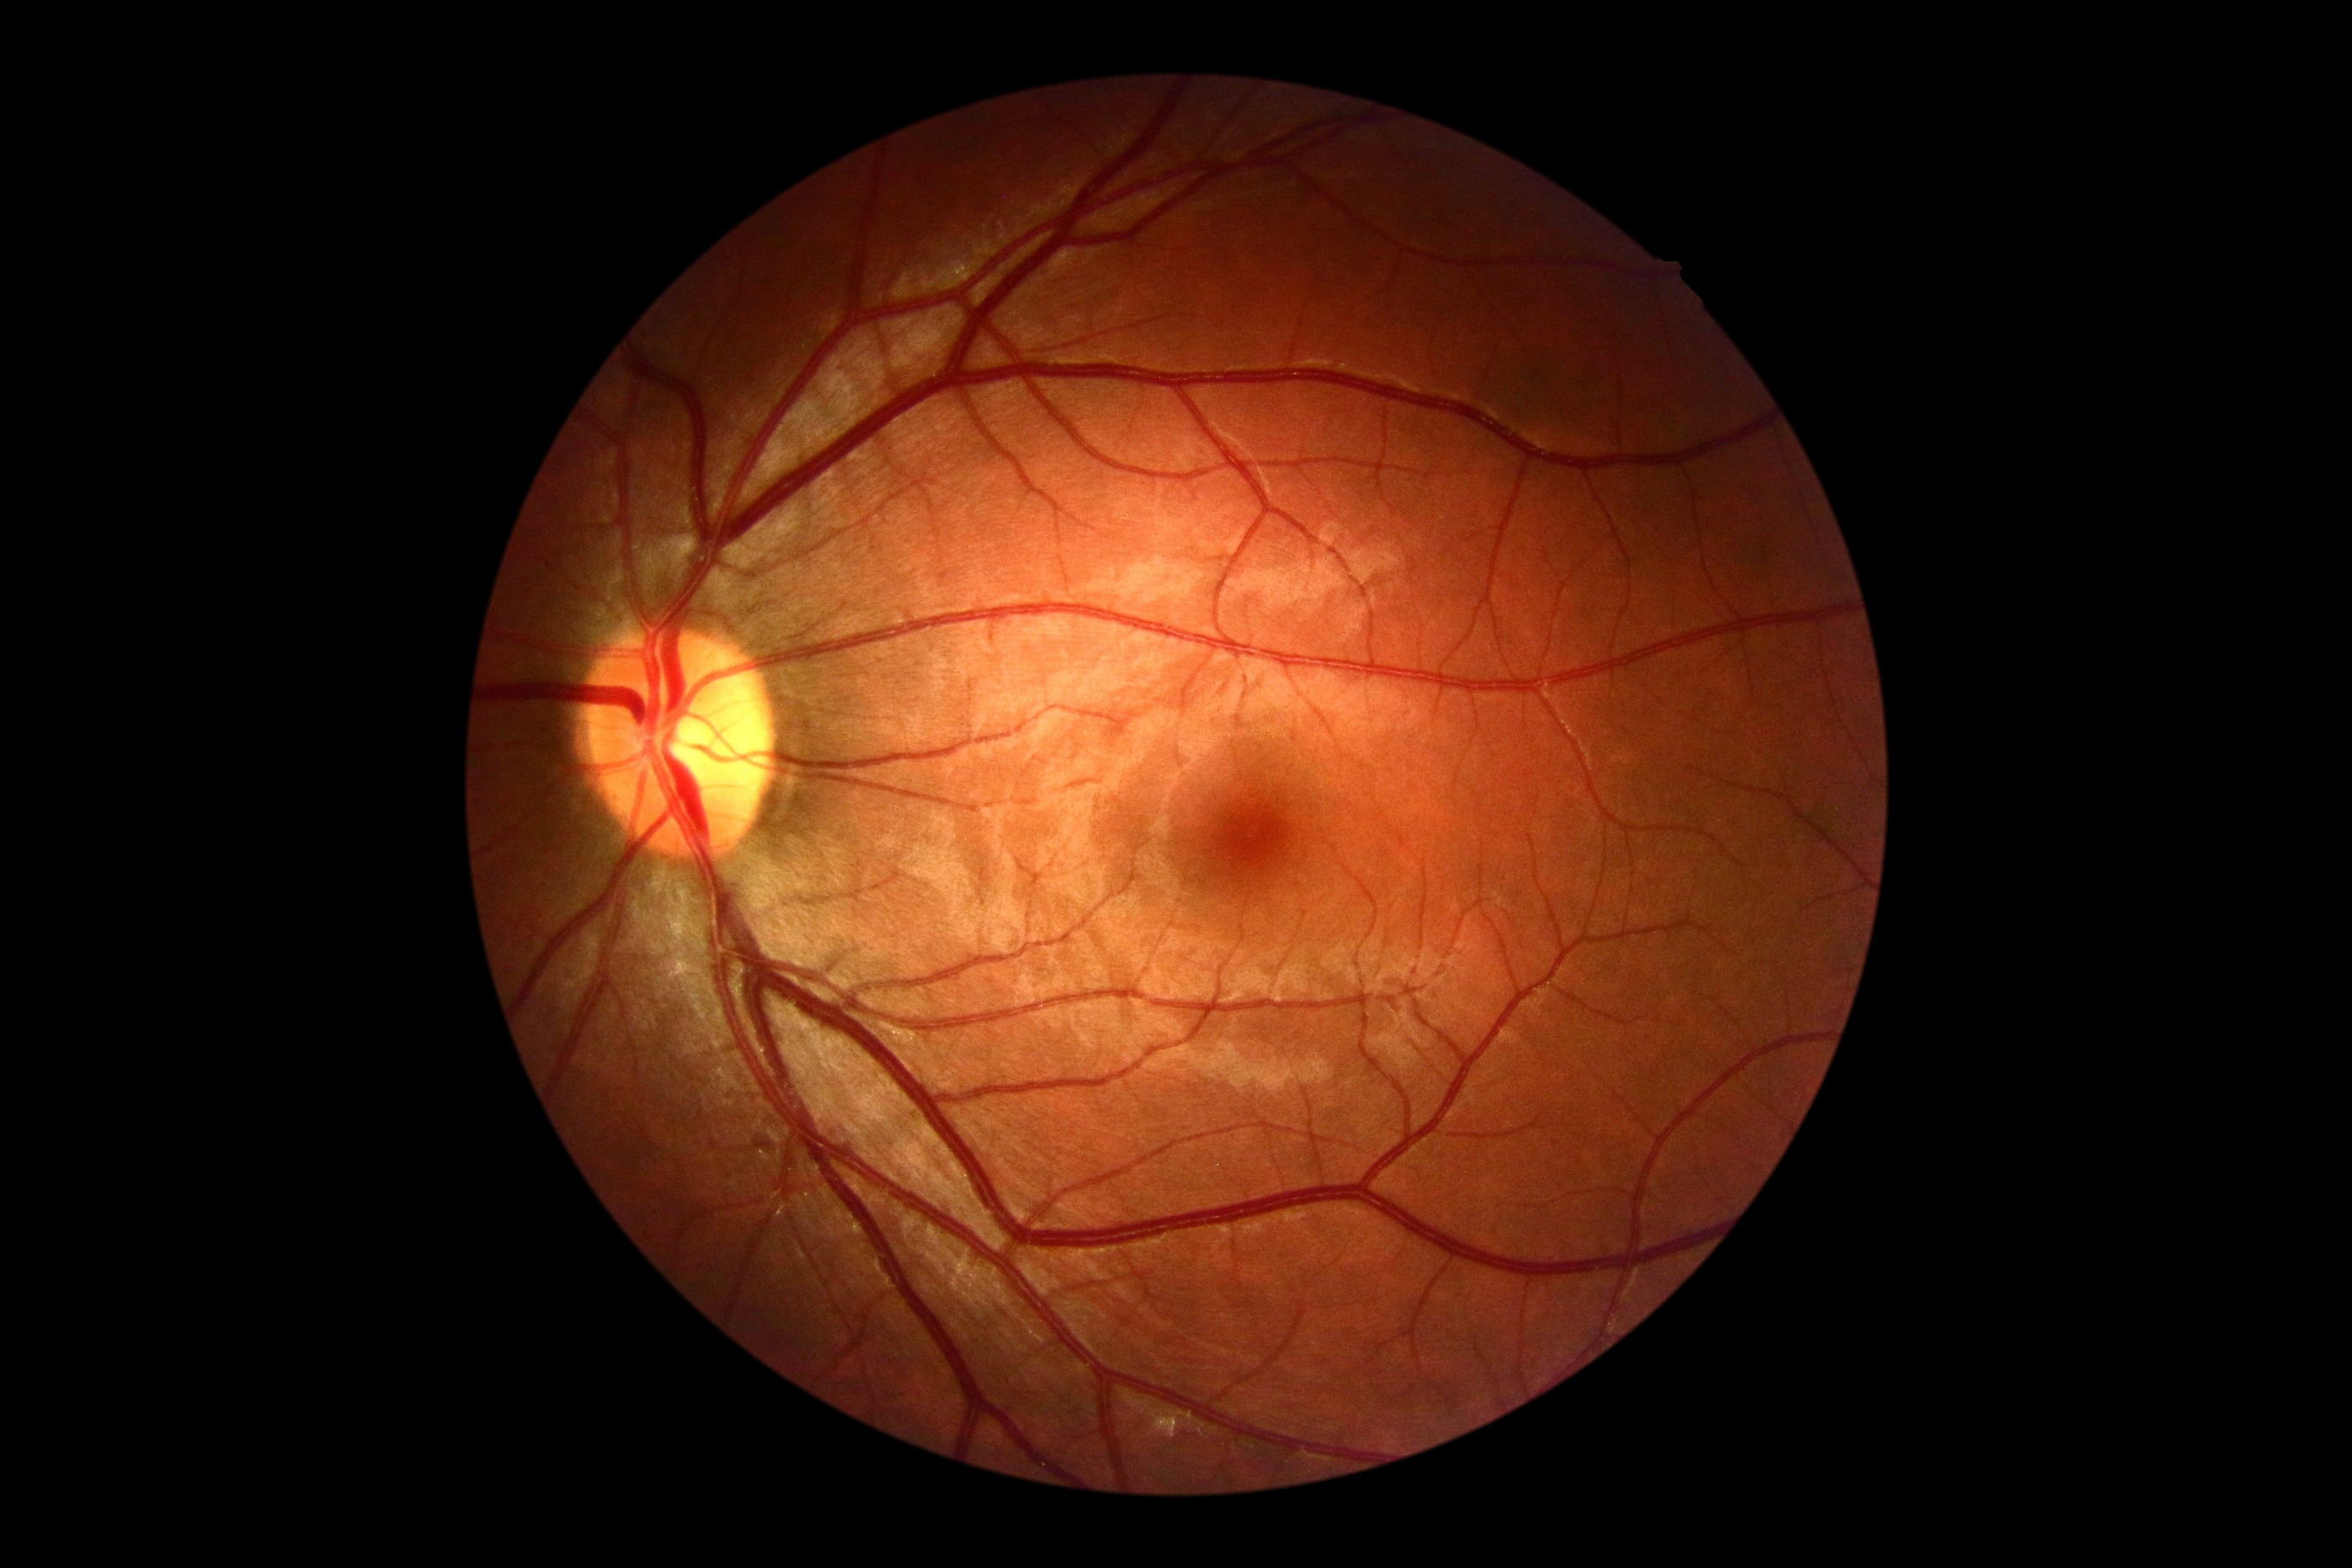 Retinopathy is grade 0.